No pharmacologic dilation; NIDEK AFC-230: 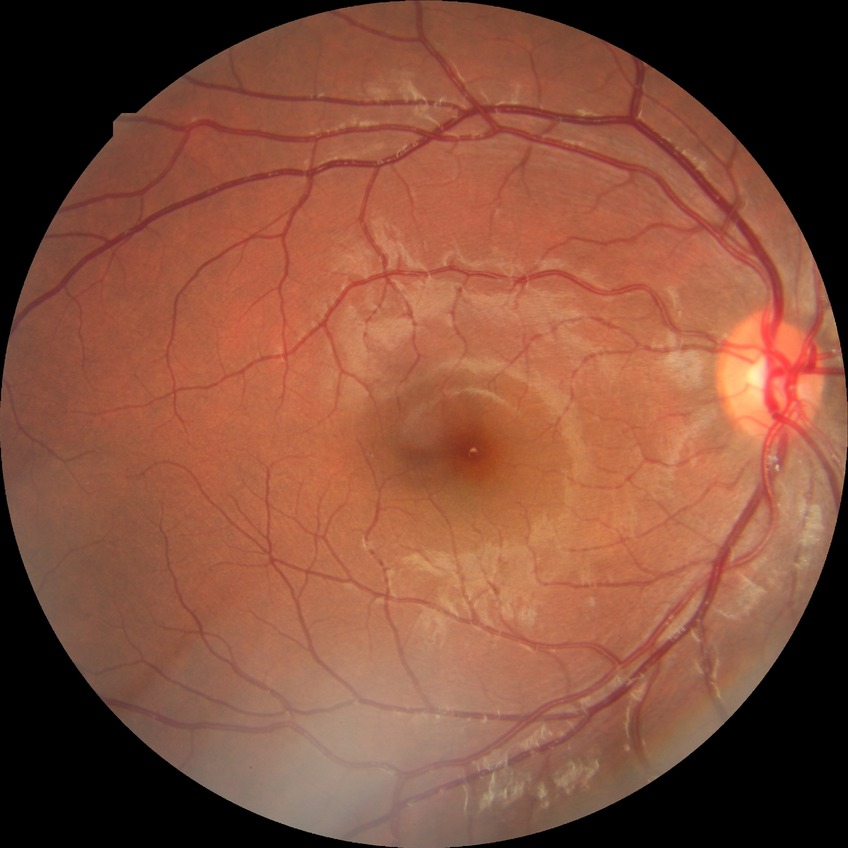
No apparent diabetic retinopathy. Modified Davis grade is NDR.